Fundus photo. Camera: Nidek AFC-330
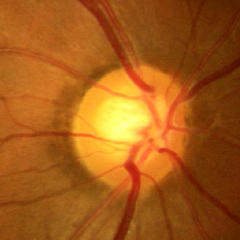
Impression = no signs of glaucoma.